CFP; 45 degree fundus photograph
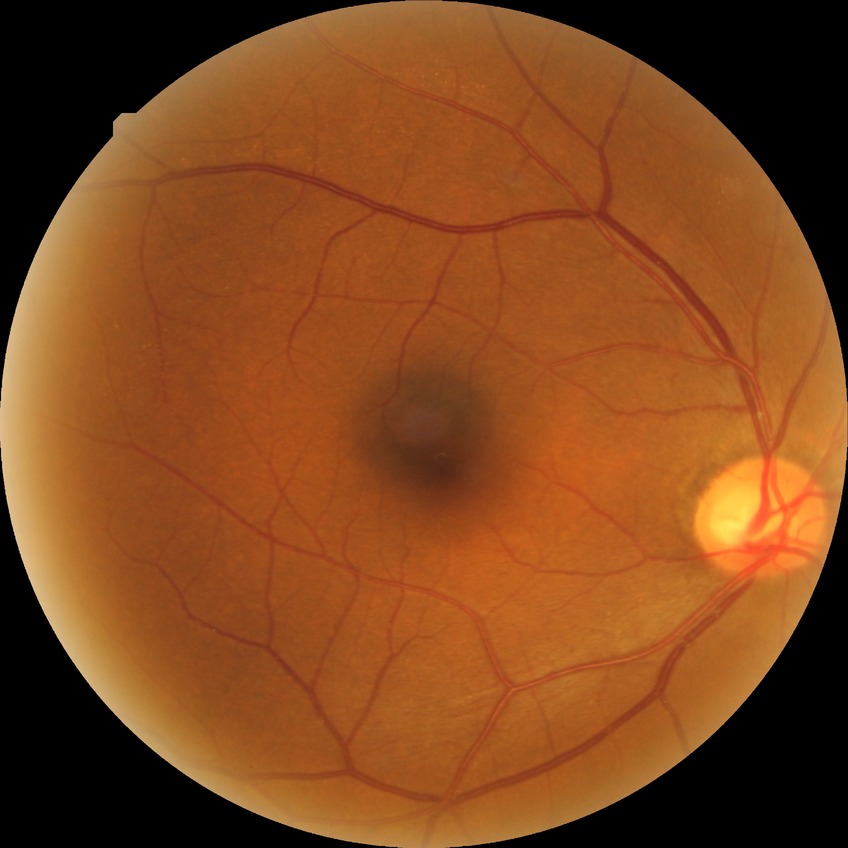 retinopathy stage: no diabetic retinopathy.